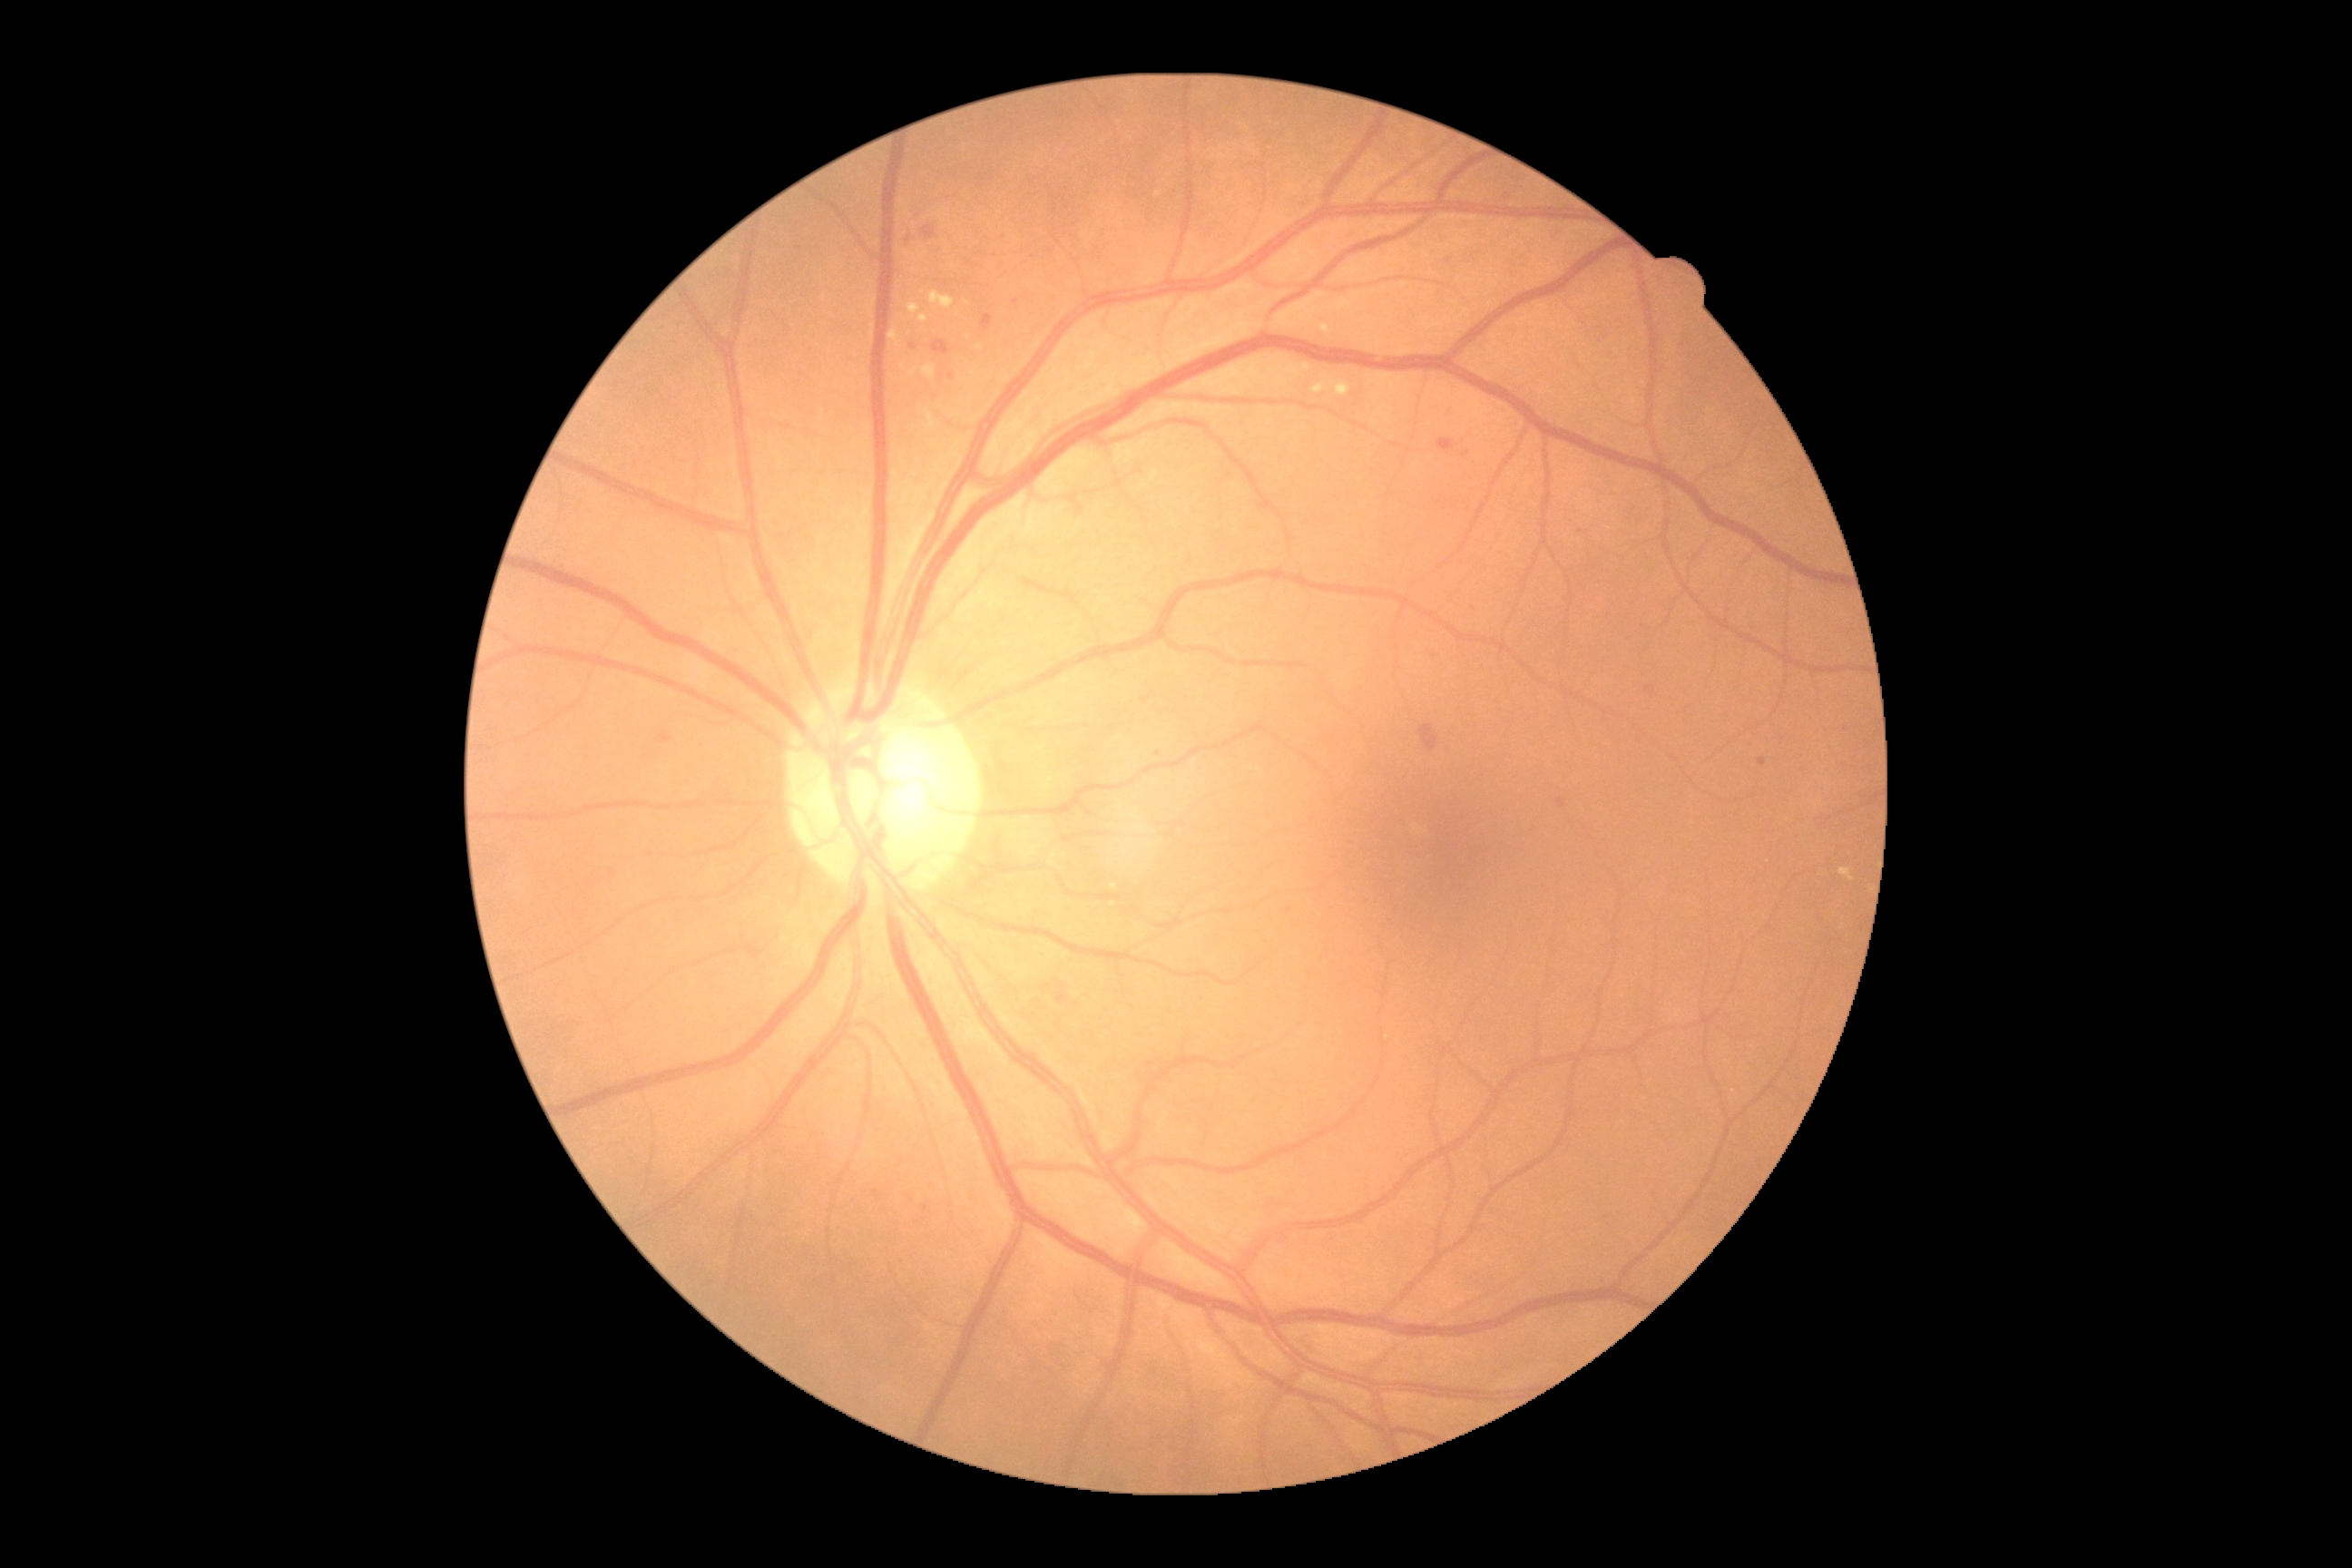

Diabetic retinopathy (DR) is moderate NPDR (grade 2); non-proliferative diabetic retinopathy. Hemorrhages (HEs) present at 1420,723,1438,754; 932,340,950,355. No soft exudates (SEs) identified. Microaneurysms (MAs) are present, including at 1558,799,1565,808; 1759,758,1767,767; 658,734,671,745; 1057,981,1068,1004; 1269,1200,1280,1208; 923,226,934,240; 923,1204,928,1213; 1647,687,1656,694; 983,315,994,331; 1438,438,1456,455. Additional small MAs near x=614, y=873; x=1507, y=198; x=913, y=347; x=1147, y=702; x=876, y=1193; x=1016, y=303; x=1290, y=911; x=951, y=376; x=1158, y=755; x=1450, y=260. Hard exudates (EXs) present at 930,291,956,309; 925,409,941,431; 908,304,921,315; 1318,324,1331,335; 1839,868,1854,881; 923,364,937,380; 1313,373,1351,397; 919,315,928,324; 1413,825,1422,834; 890,331,903,348; 975,346,983,351; 908,369,917,377. Additional small EXs near x=968, y=338; x=923, y=293; x=1114, y=887; x=1158, y=194; x=902, y=367.